FOV: 45 degrees: 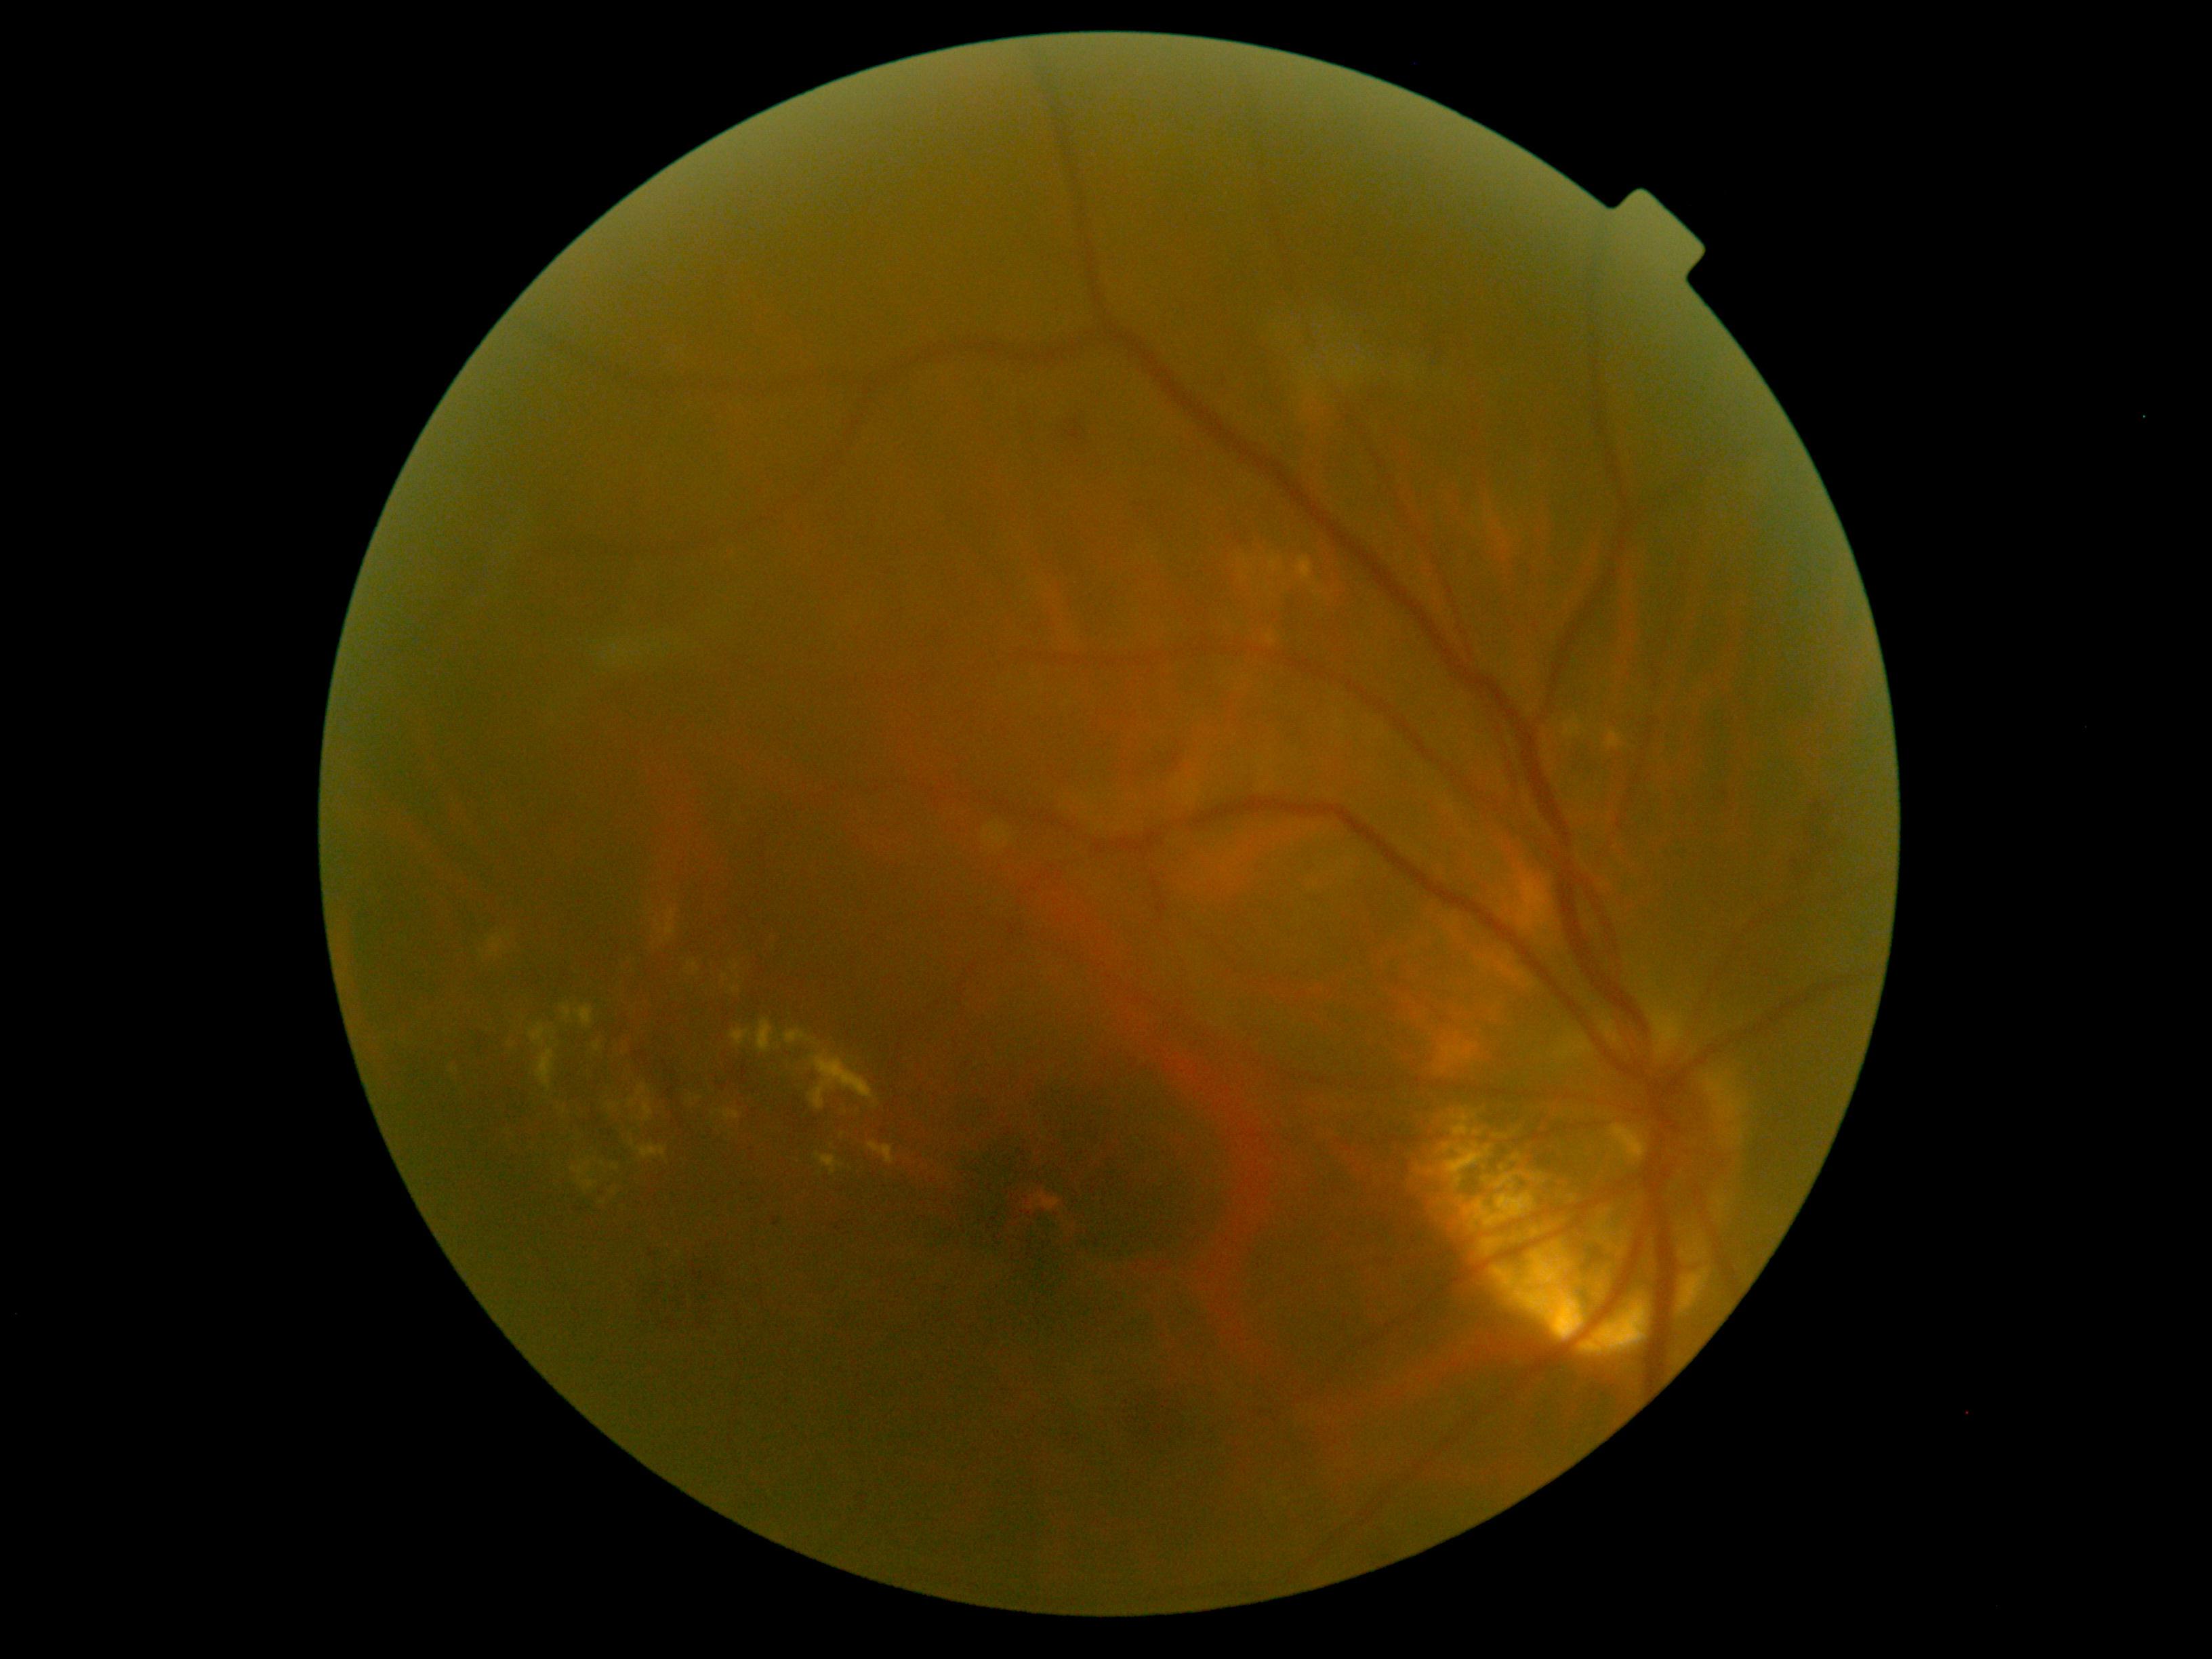
DR stage: grade 2 (moderate NPDR) — more than just microaneurysms but less than severe NPDR.